Acquired on the Phoenix ICON. 1240x1240. Wide-field fundus photograph from neonatal ROP screening.
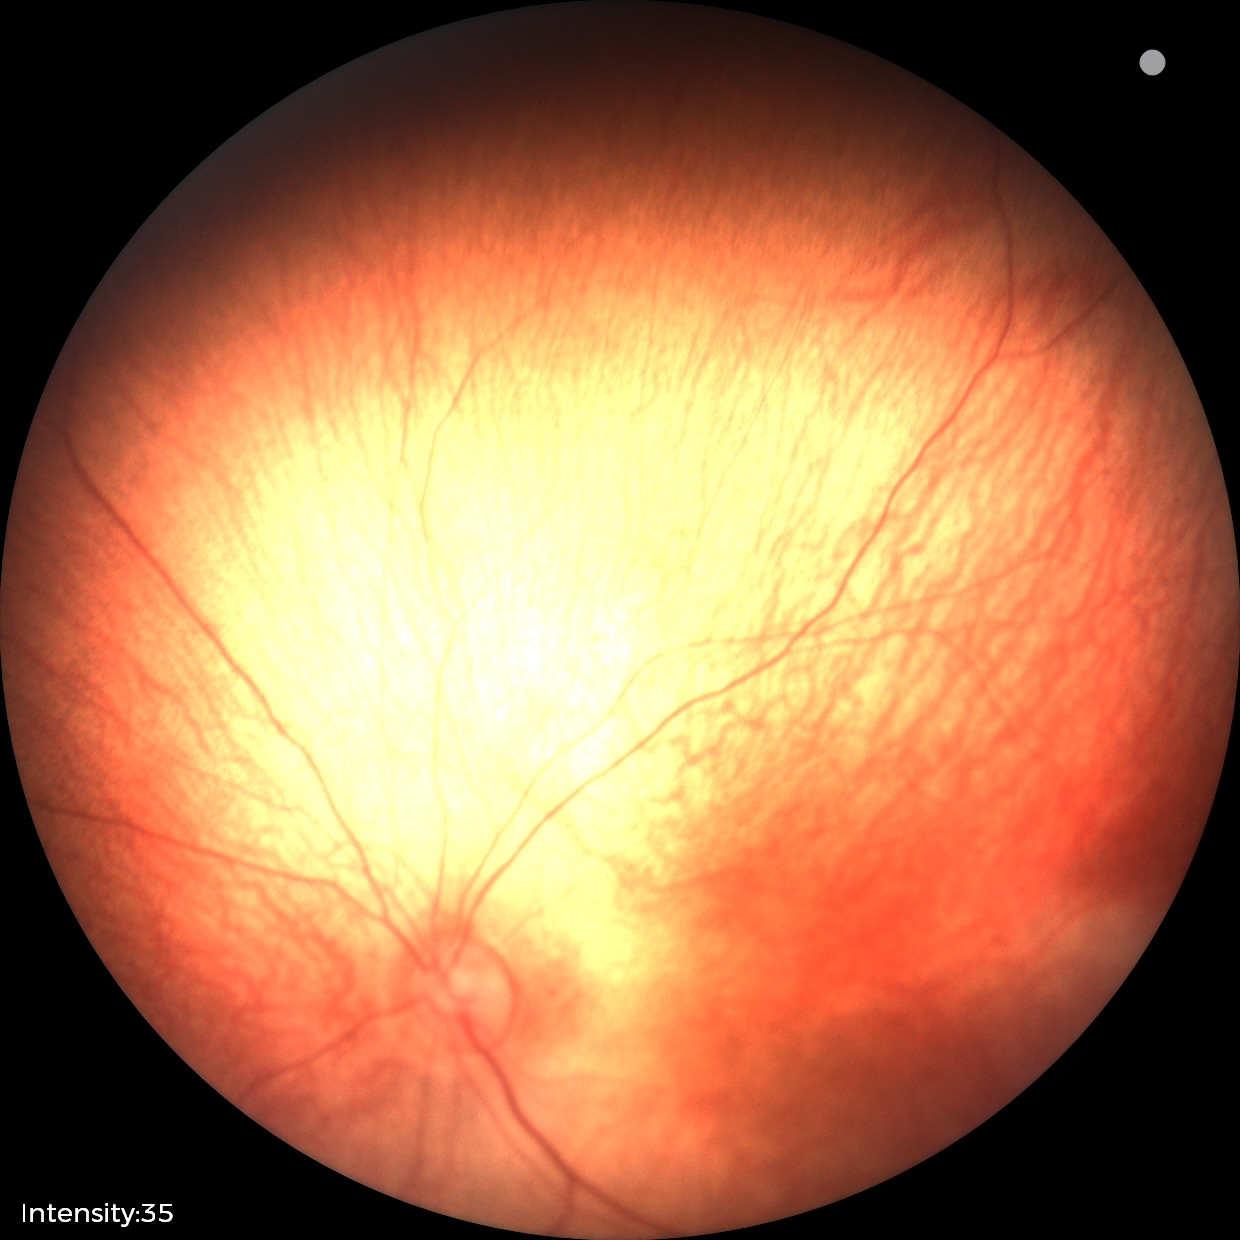

Physiological retinal appearance for postconceptual age.